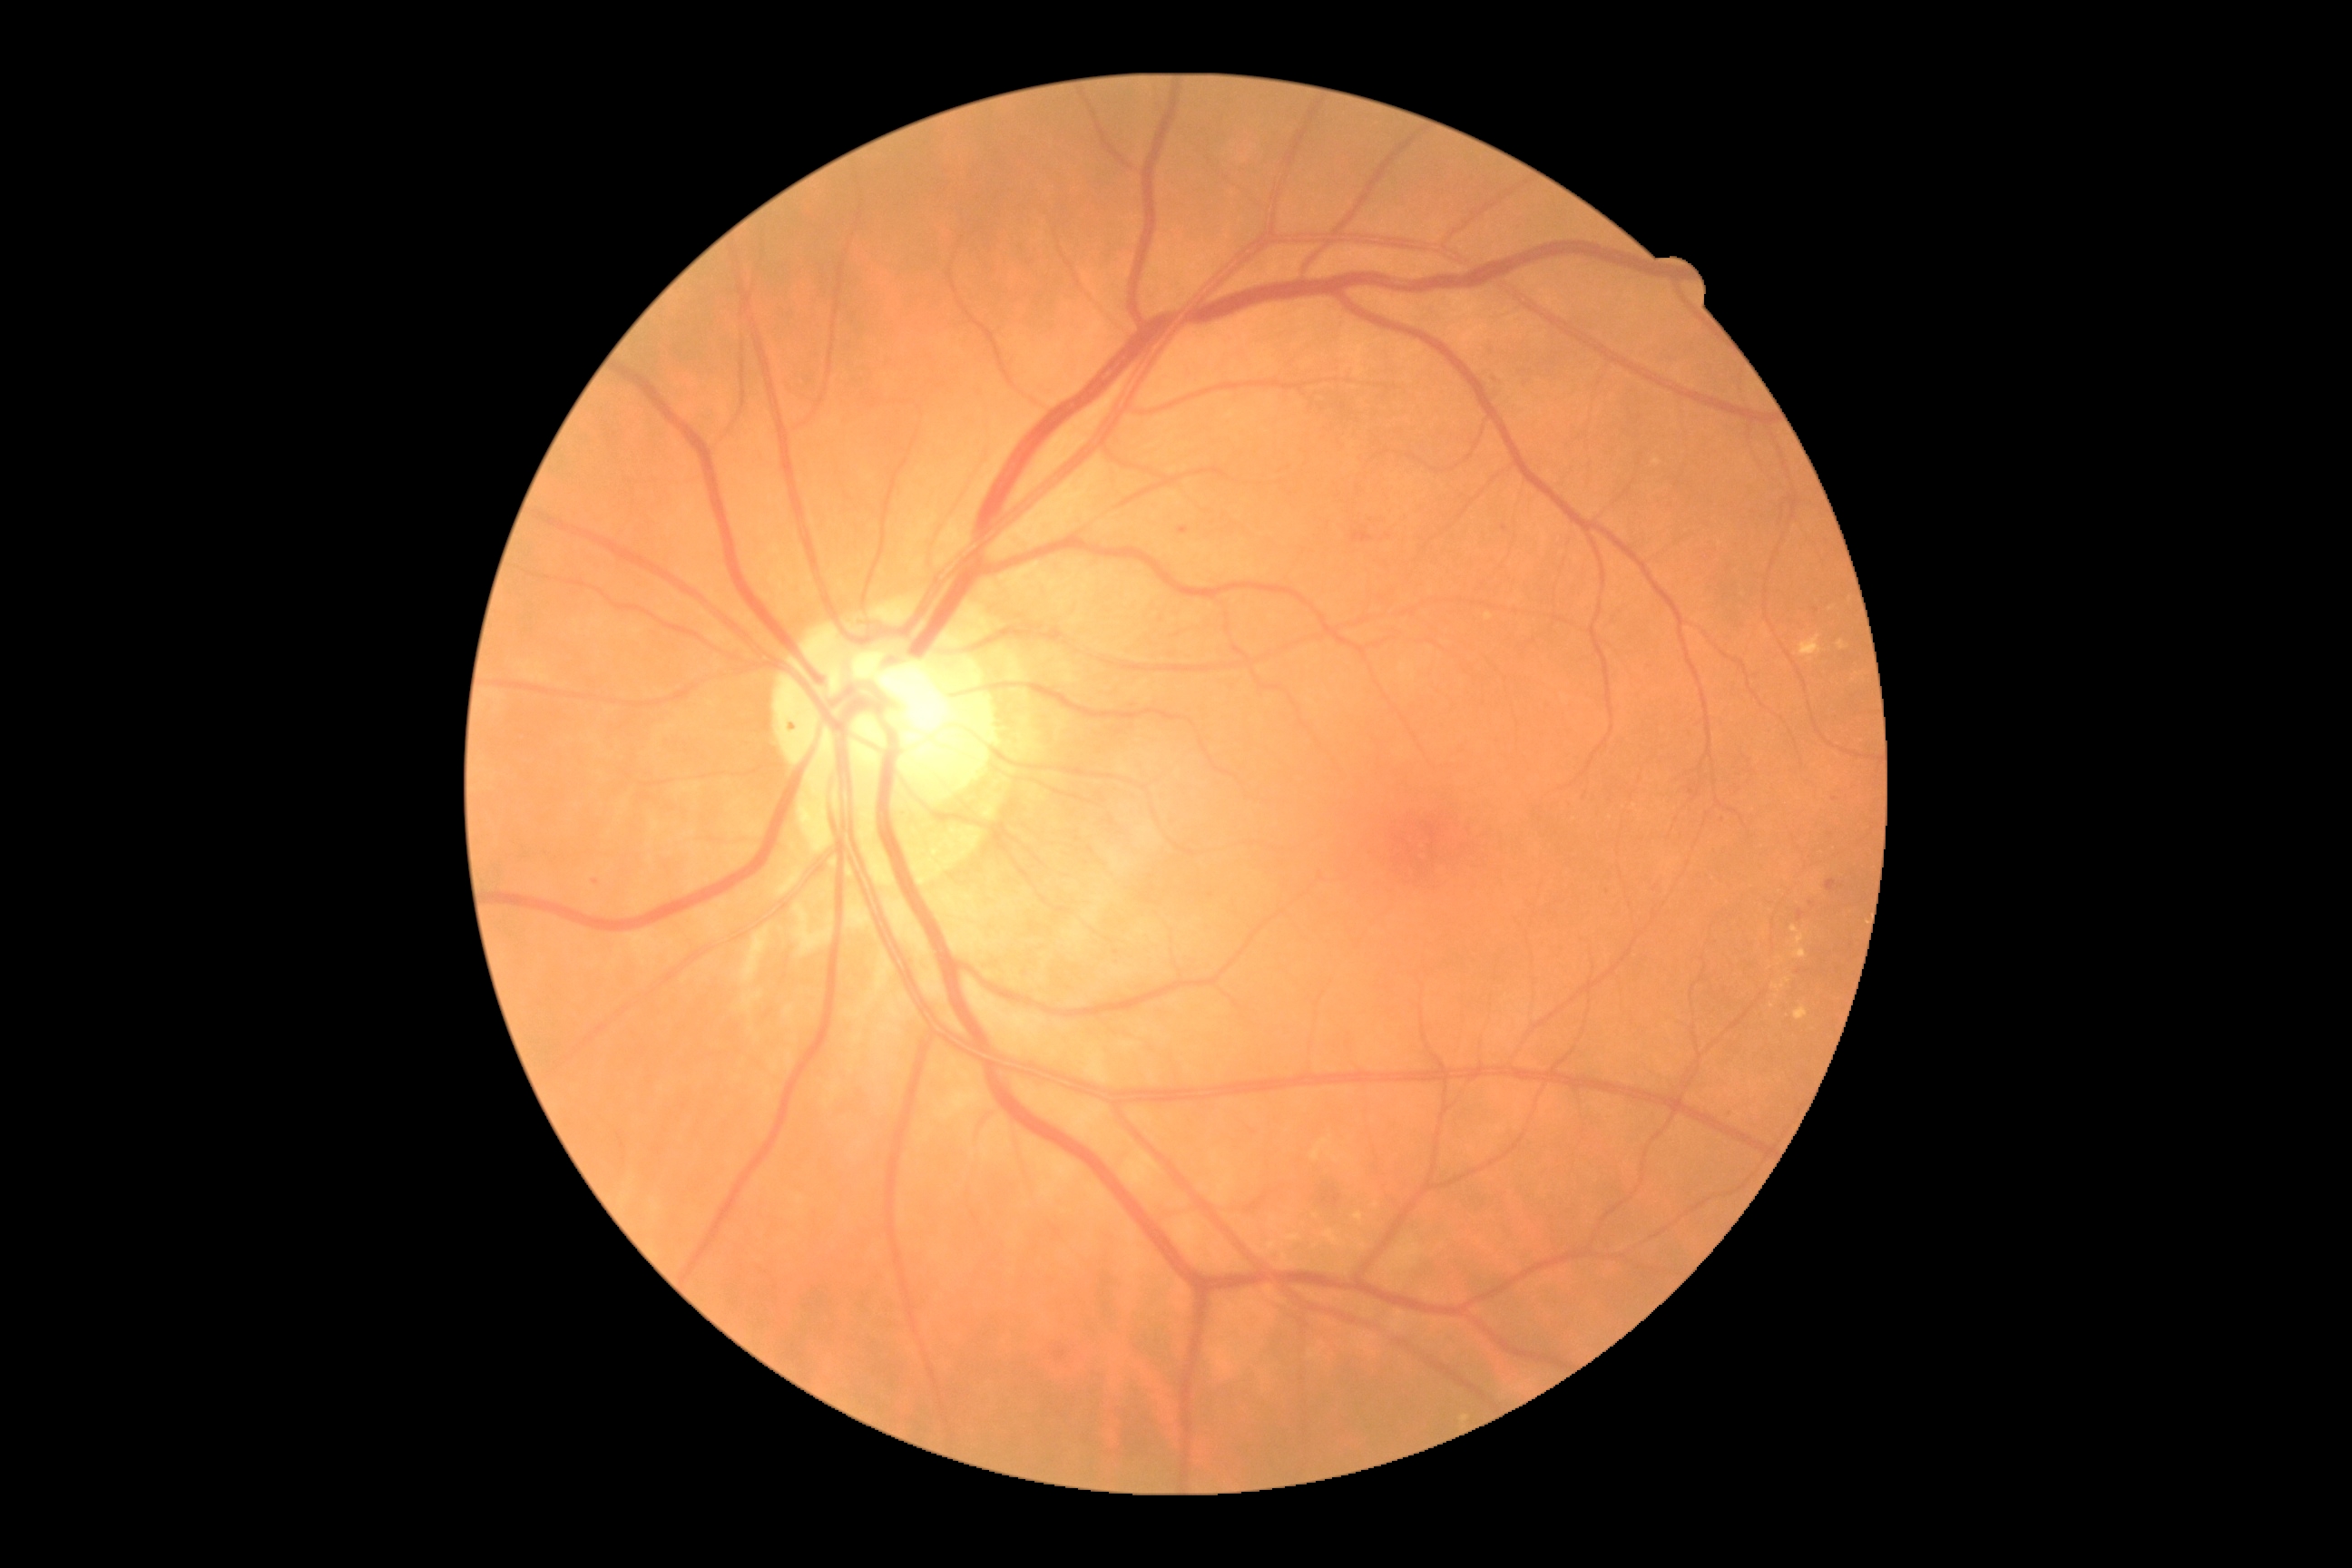 DR: grade 2 (moderate NPDR)
A subset of detected lesions:
EXs (more not shown): 1311, 1139, 1331, 1161 | 1268, 1242, 1277, 1250 | 1253, 1246, 1268, 1255 | 1792, 926, 1805, 946 | 1794, 1008, 1808, 1021 | 1357, 1240, 1367, 1250 | 1355, 1213, 1364, 1226 | 1271, 1226, 1279, 1231
EXs (small, approximate centers) near x=1375, y=1206 | x=1315, y=1217 | x=1787, y=981